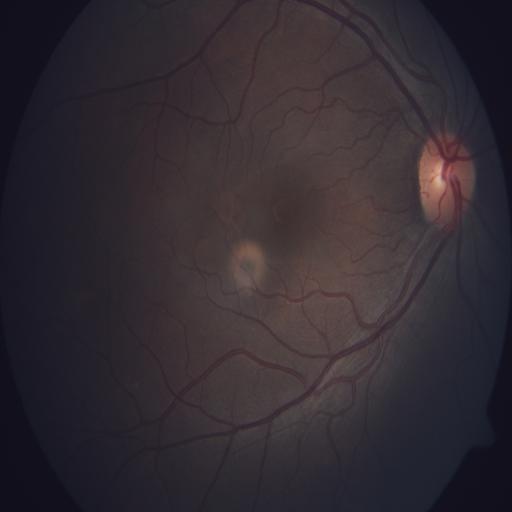
No retinal pathology identified.